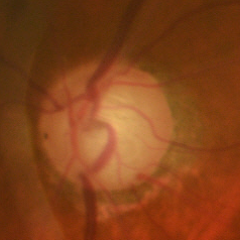
The image shows early glaucomatous optic neuropathy. Diagnostic criteria: glaucomatous retinal nerve fiber layer defects on red-free fundus photography without visual field defects.